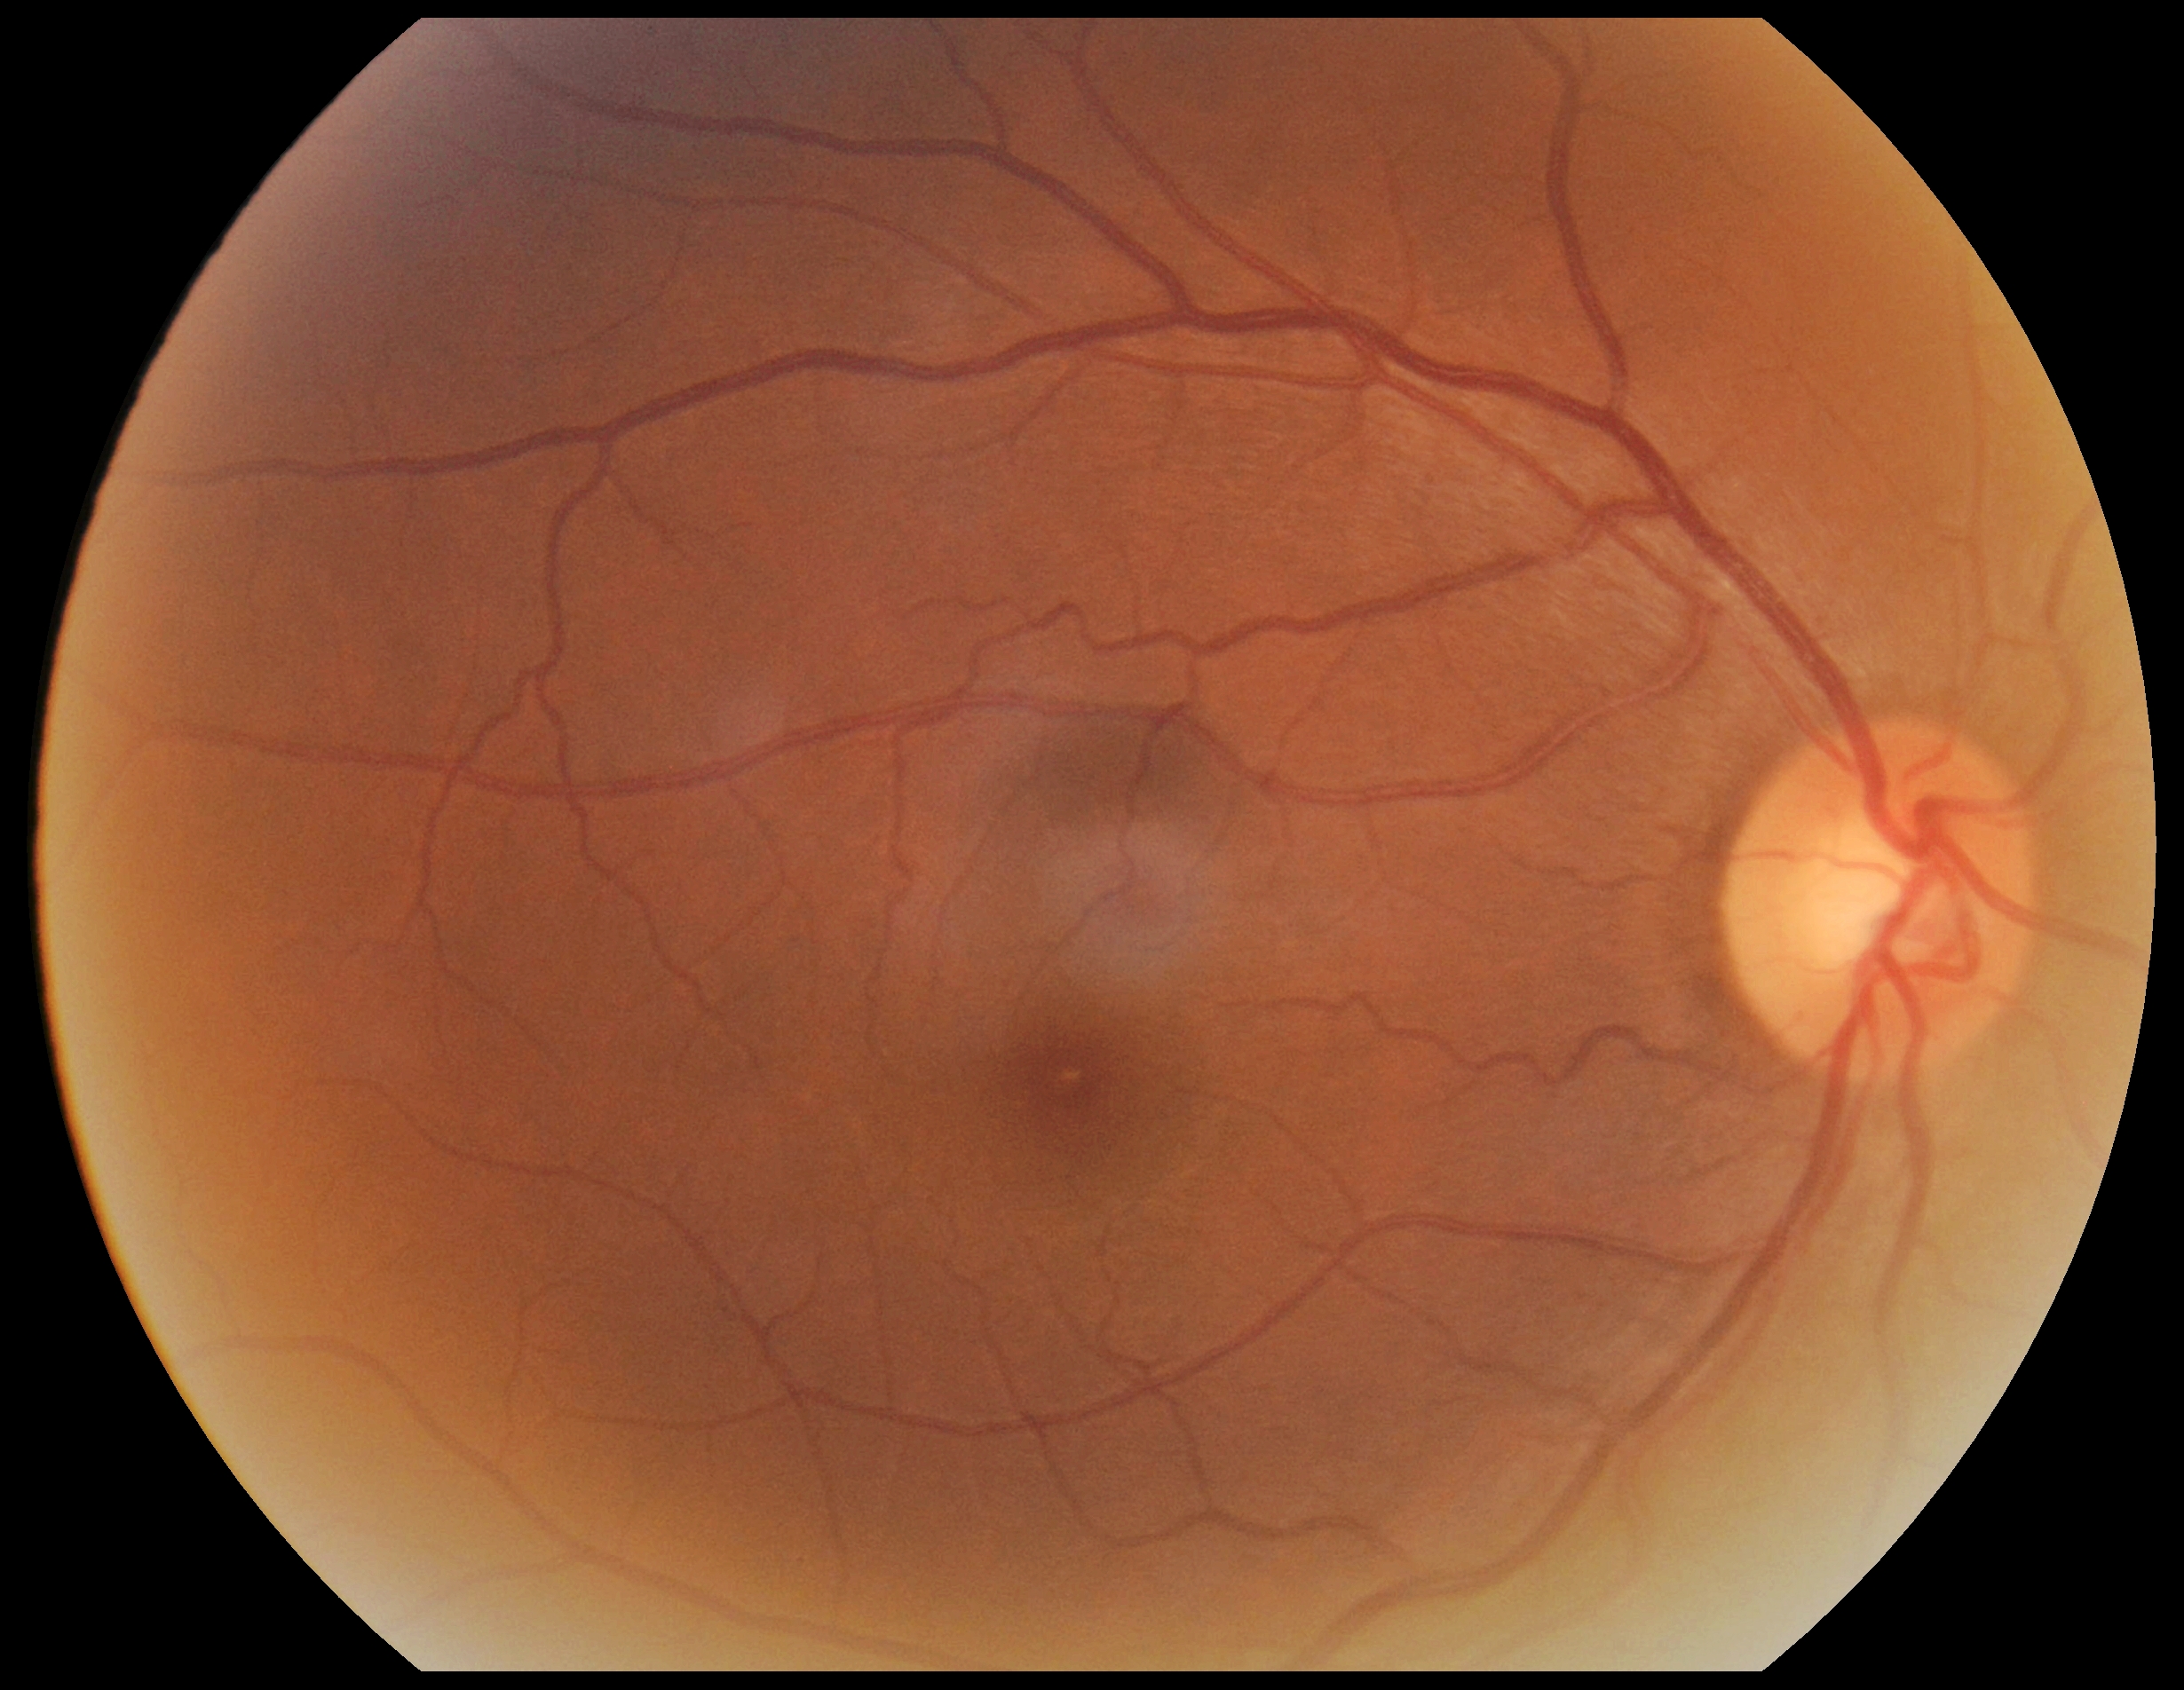

Diabetic retinopathy (DR) is grade 0 (no apparent retinopathy).